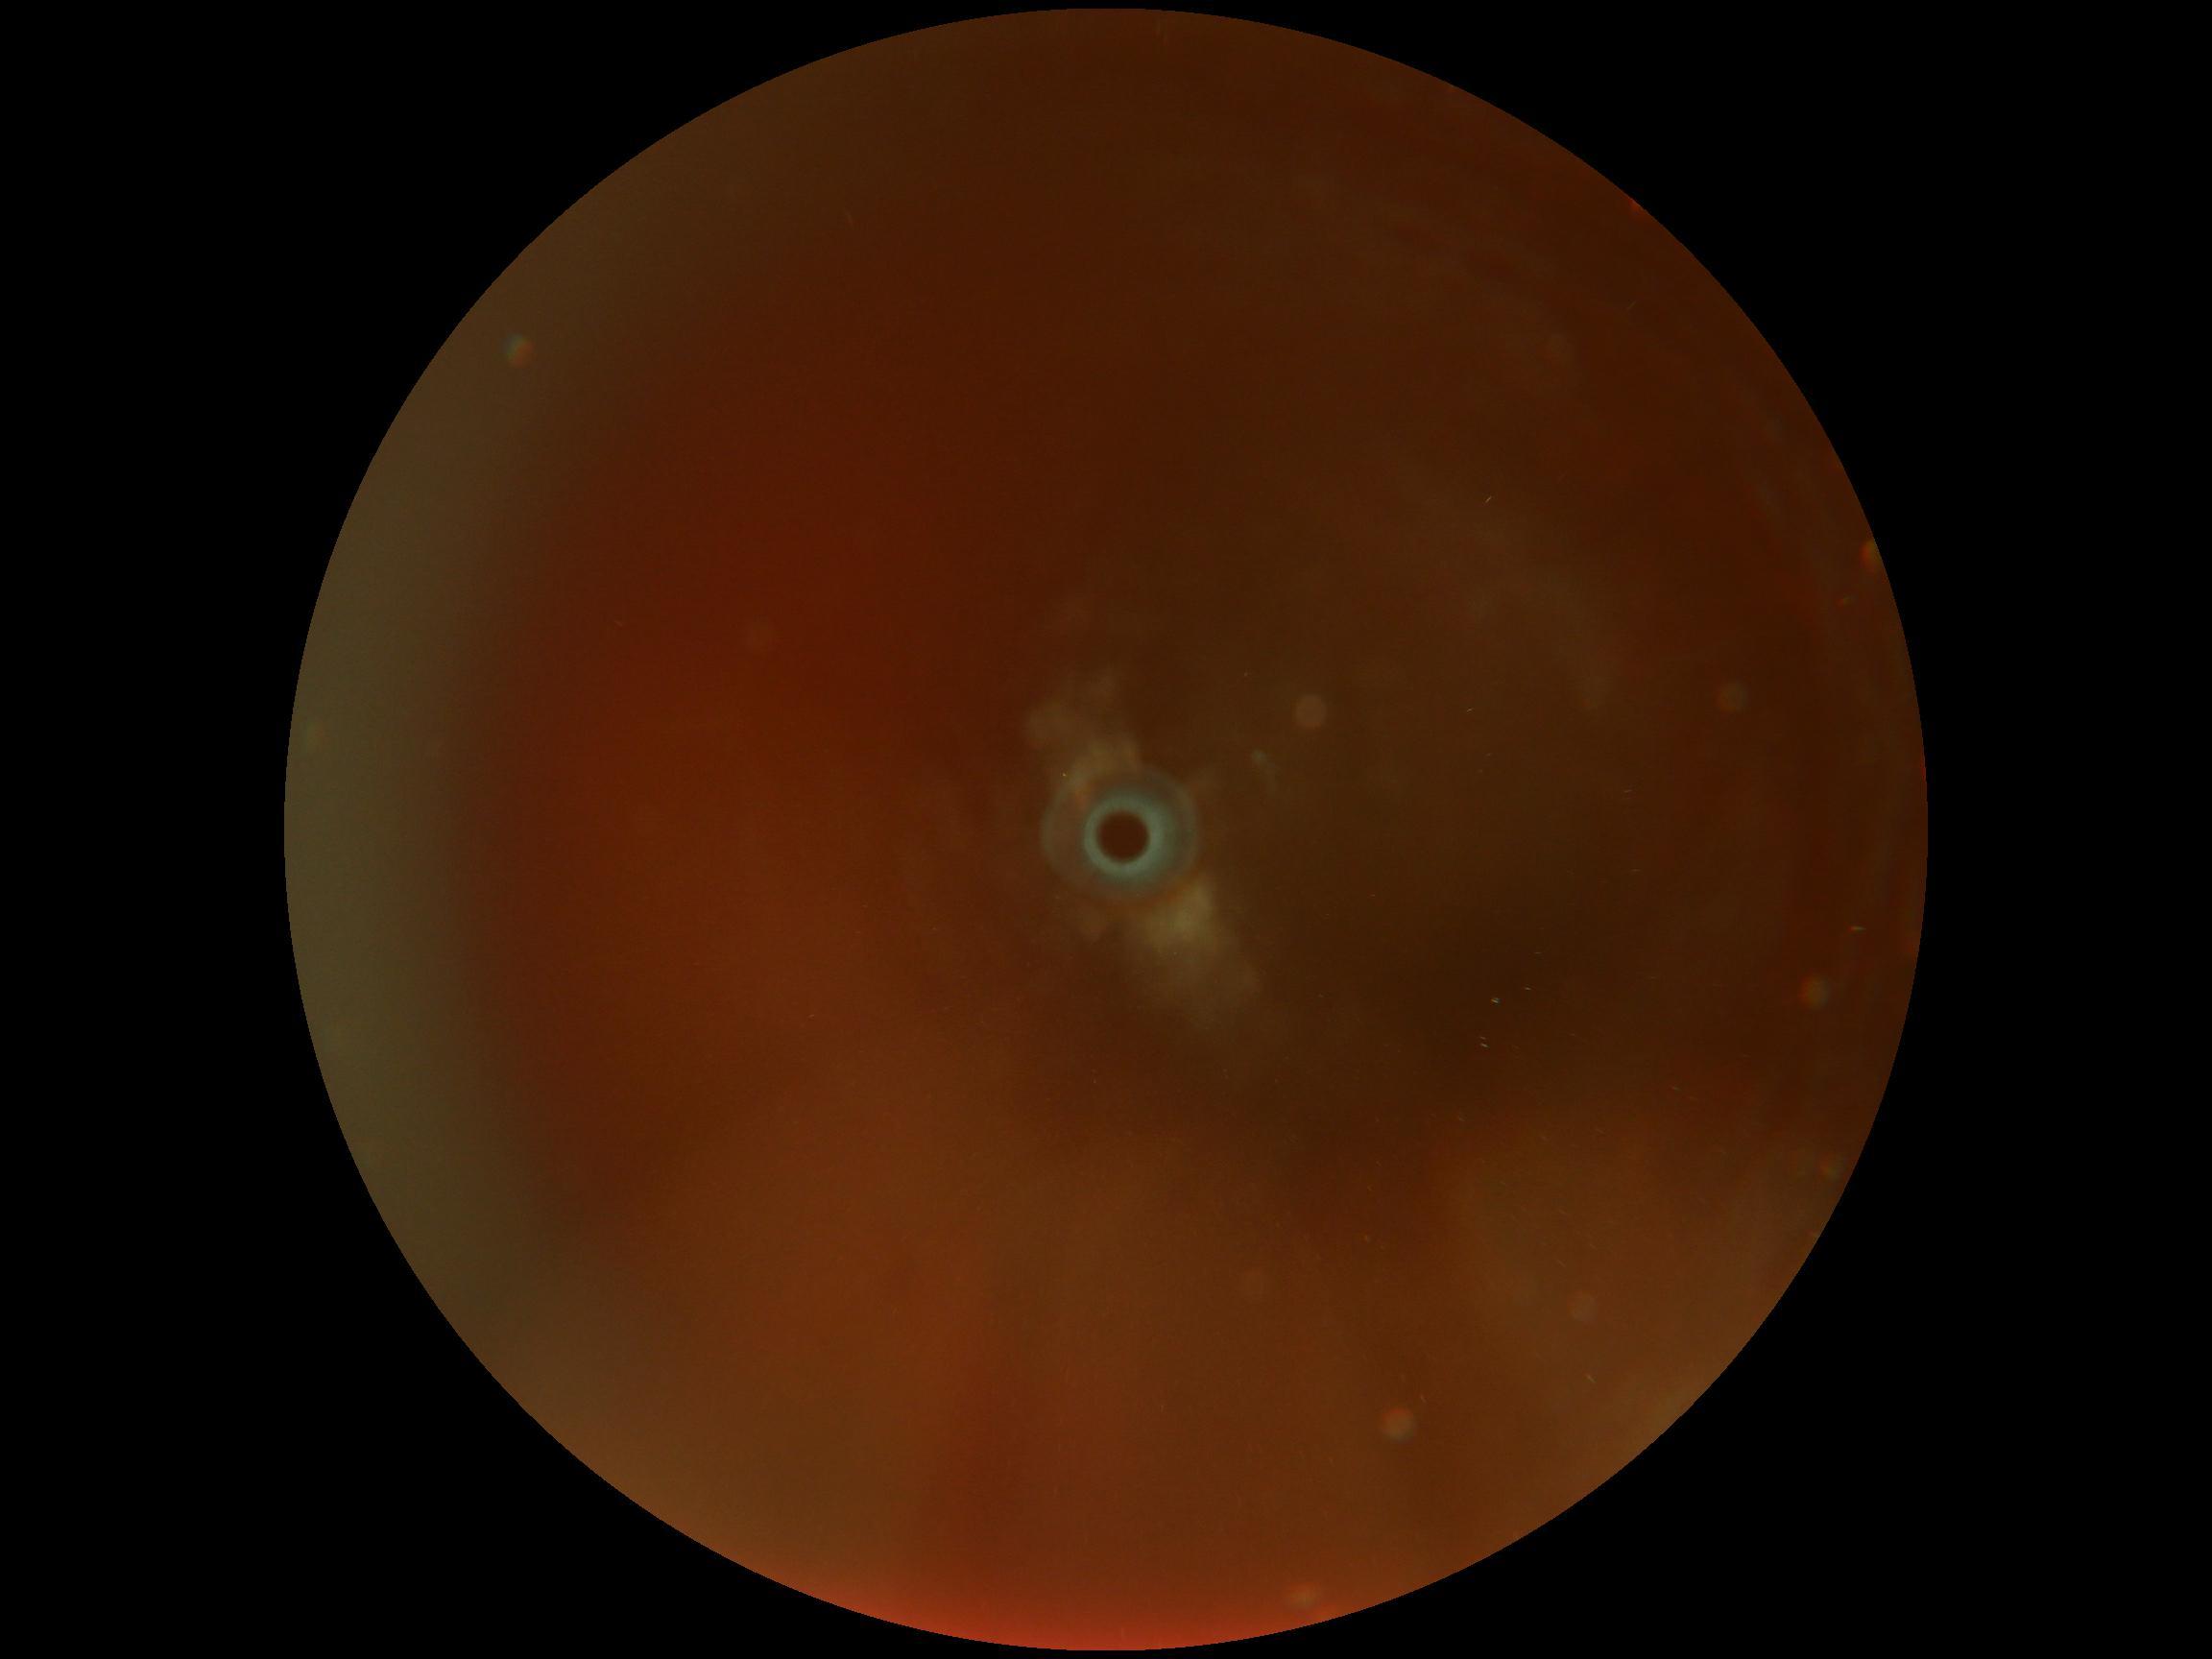
Retinopathy grade is ungradable due to poor image quality.